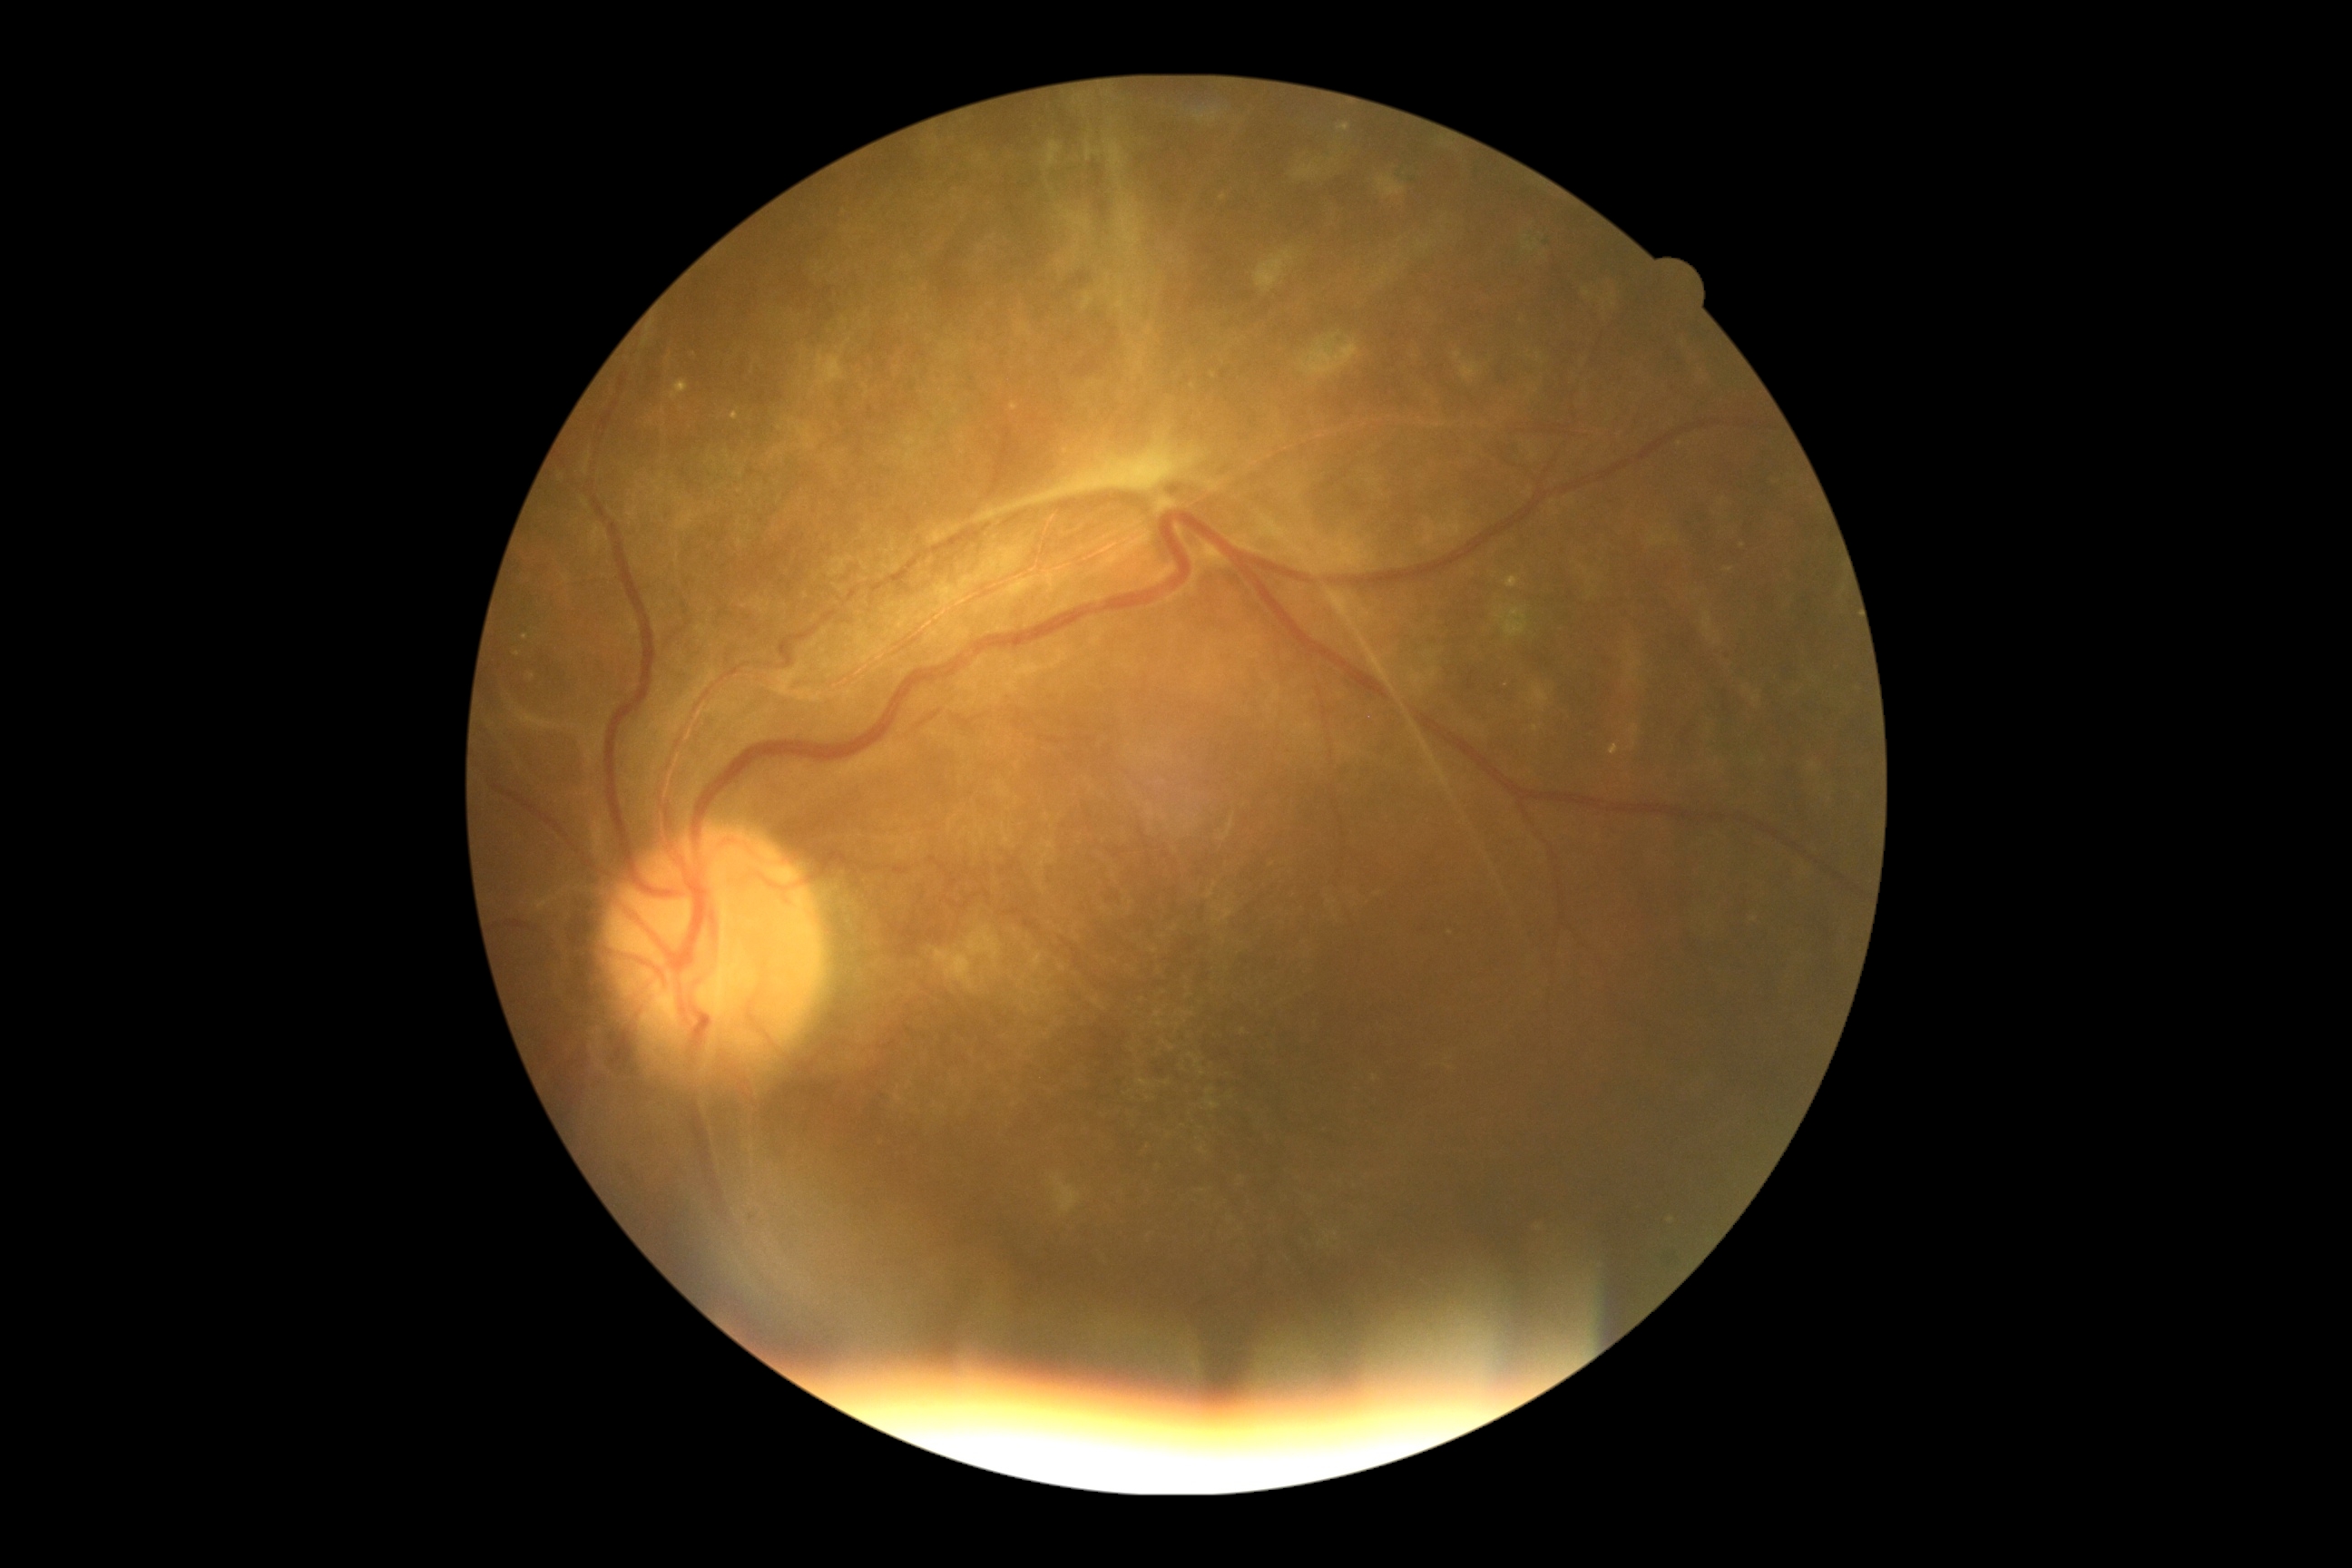

DR severity: grade 4.